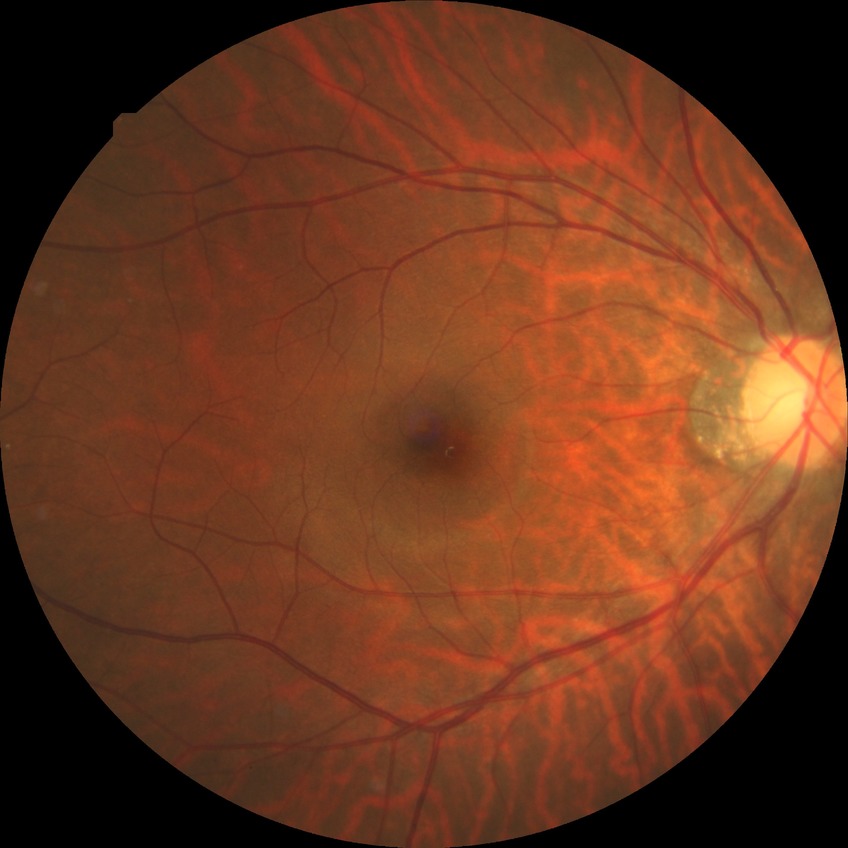 diabetic retinopathy severity: no diabetic retinopathy.